Color fundus image. Optic disc-centered crop — 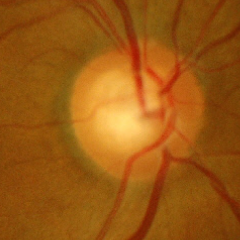

Demonstrates early glaucoma.